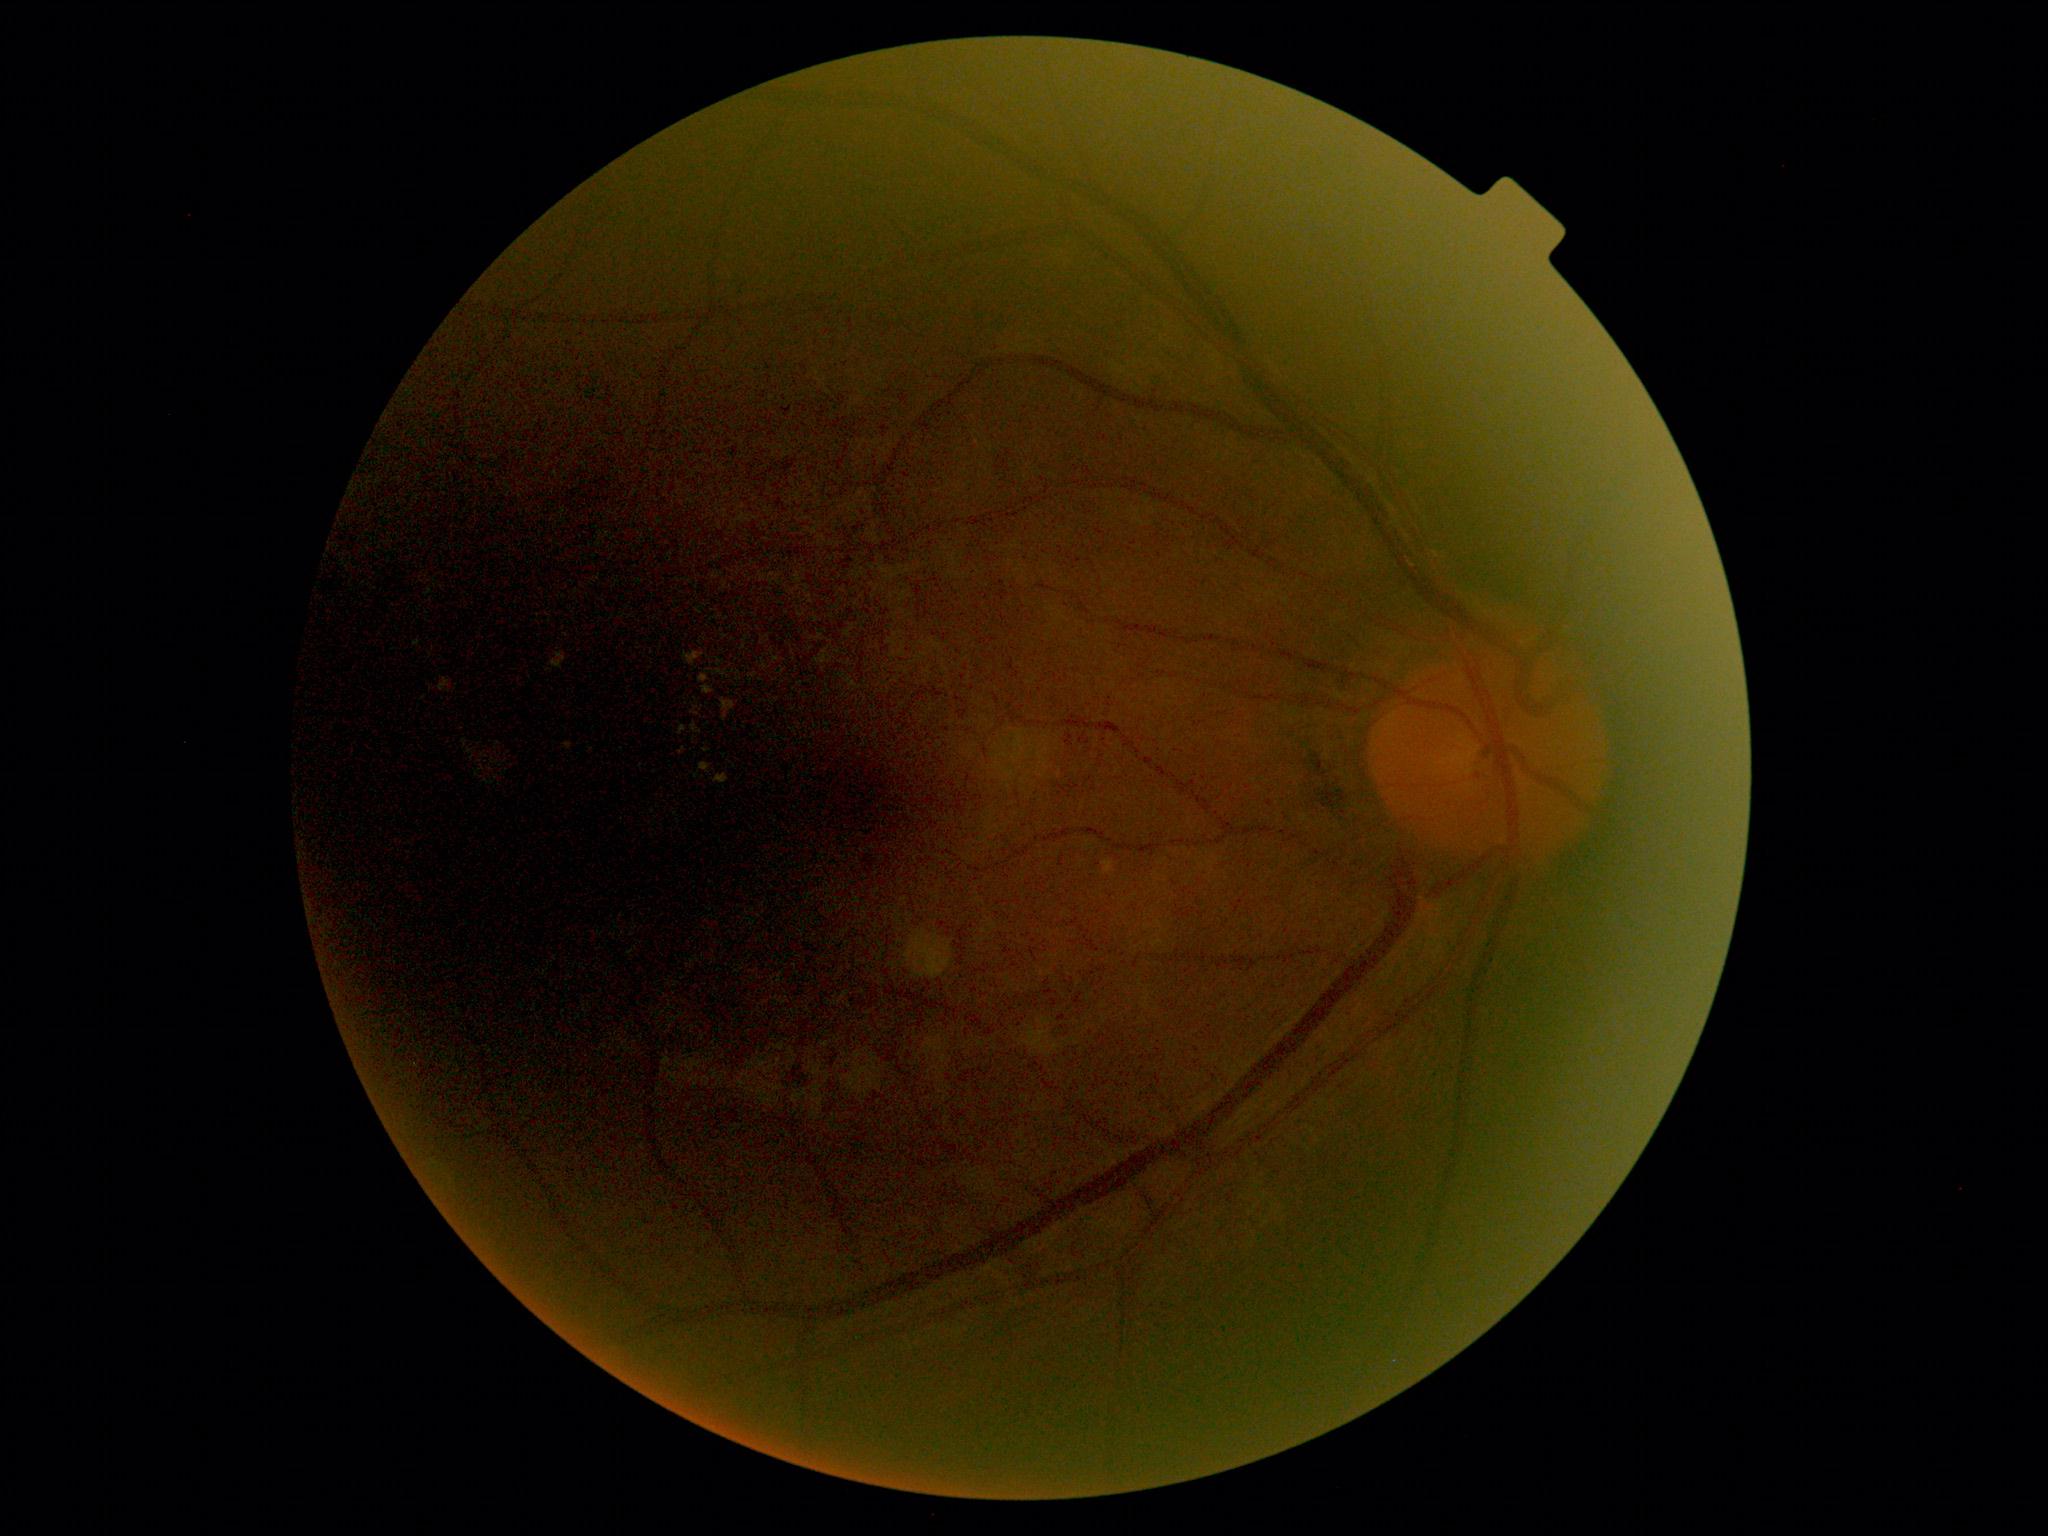

Diabetic retinopathy (DR): moderate non-proliferative diabetic retinopathy (grade 2).